Pediatric retinal photograph (wide-field). 1240x1240 — 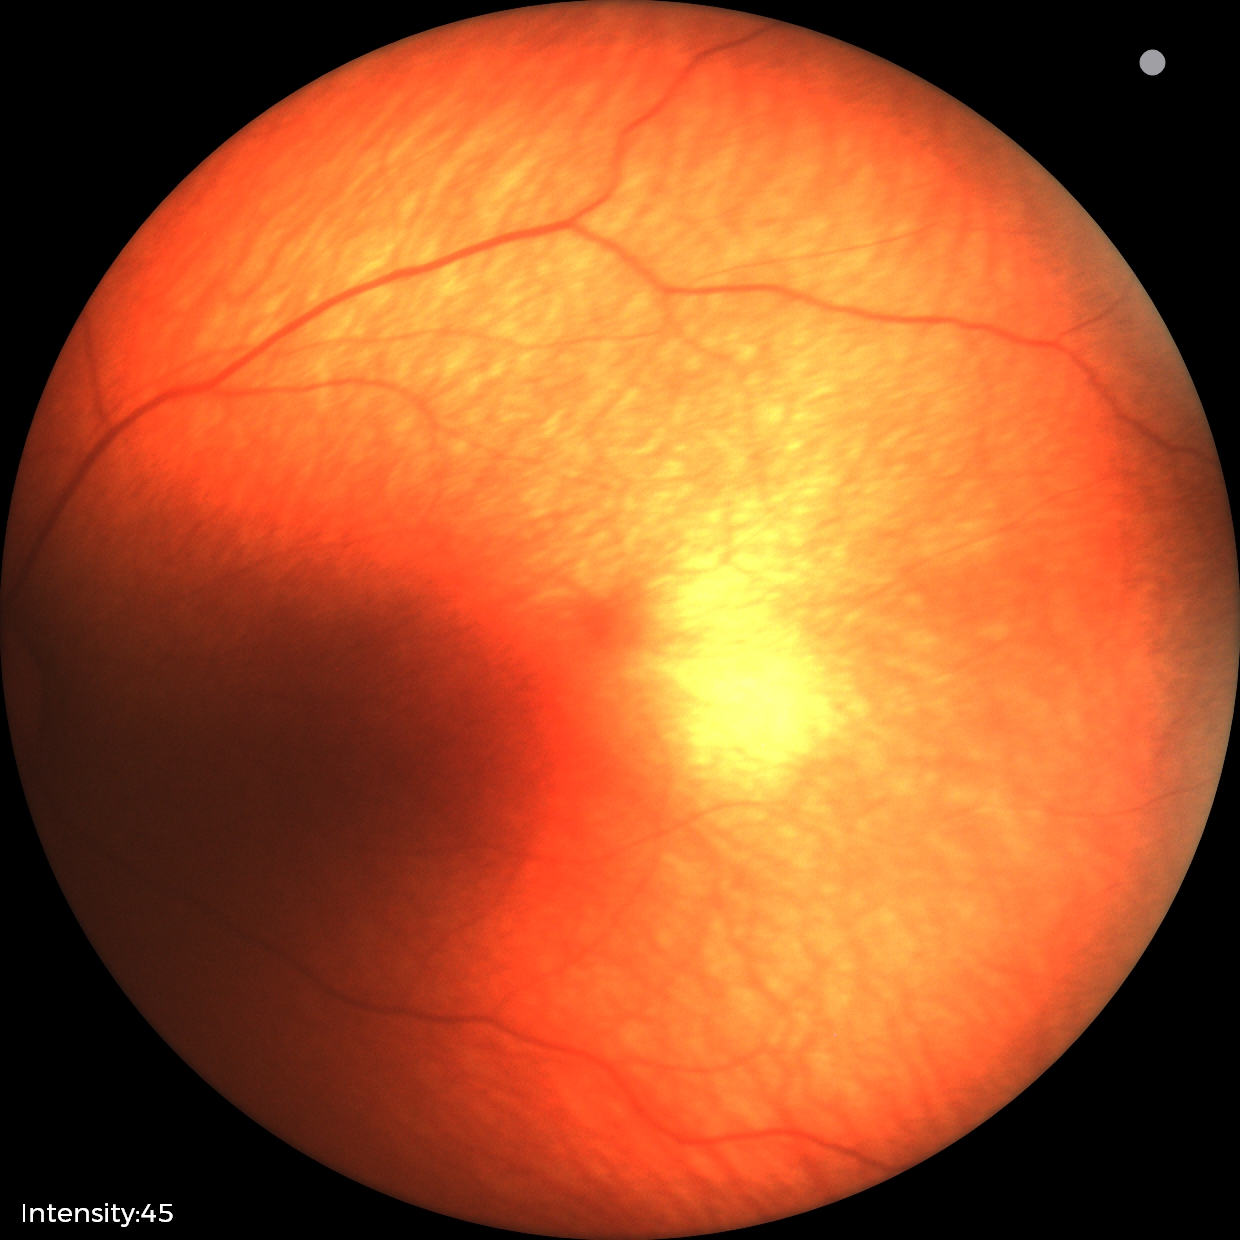 No retinal pathology identified on screening.